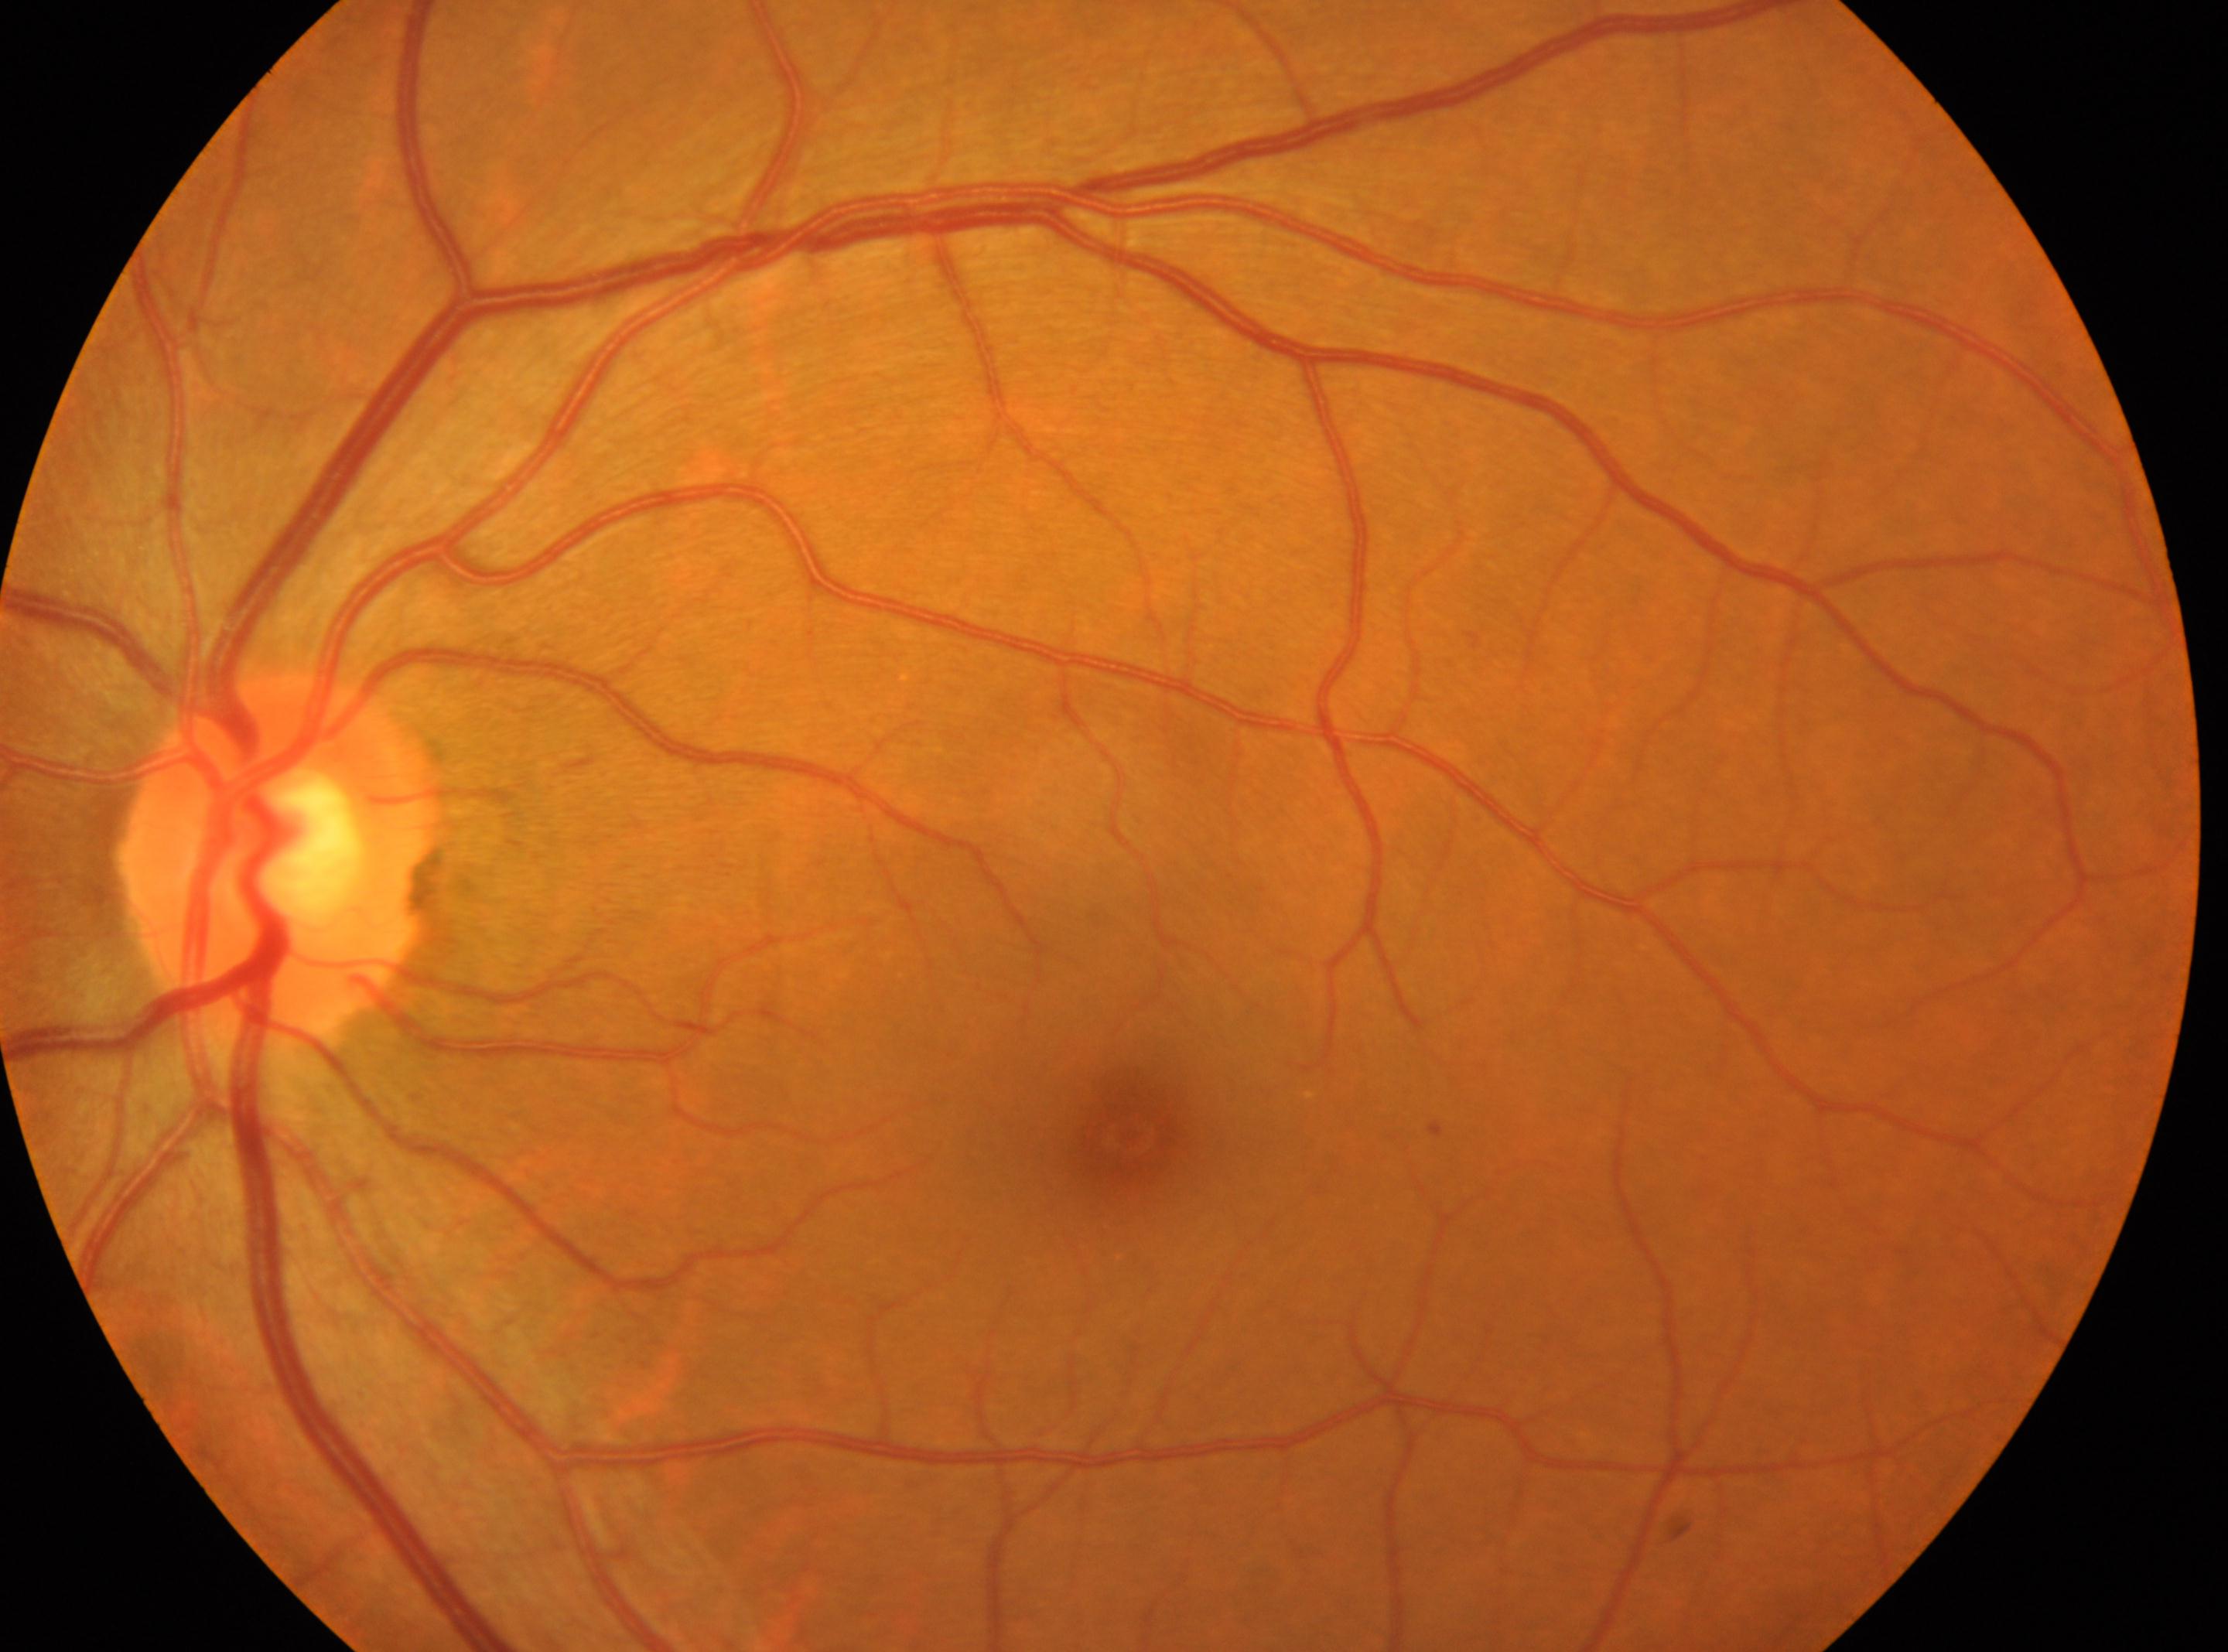
Q: What is the DR grade?
A: 1/4
Q: Where is the fovea?
A: 1131px, 1134px
Q: Where is the optic disc?
A: 275px, 858px
Q: Which eye is imaged?
A: oculus sinister